Color fundus image; 848 by 848 pixels; without pupil dilation
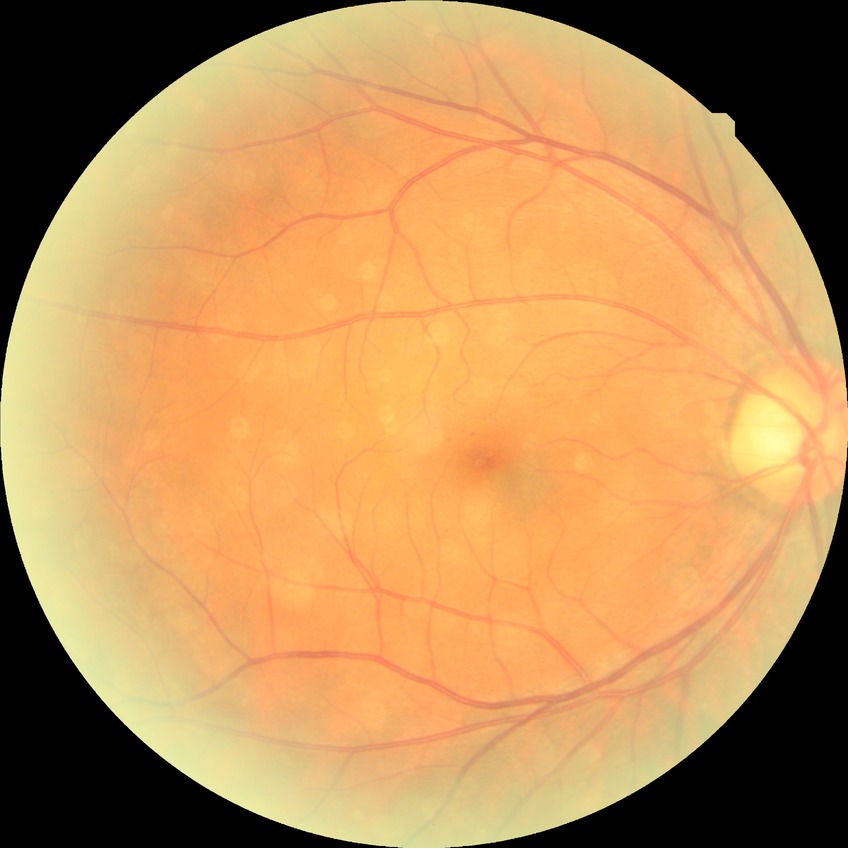
{
  "davis_grade": "SDR",
  "proliferative_class": "non-proliferative diabetic retinopathy"
}